Wide-field contact fundus photograph of an infant · 640 by 480 pixels · camera: Clarity RetCam 3 (130° FOV) — 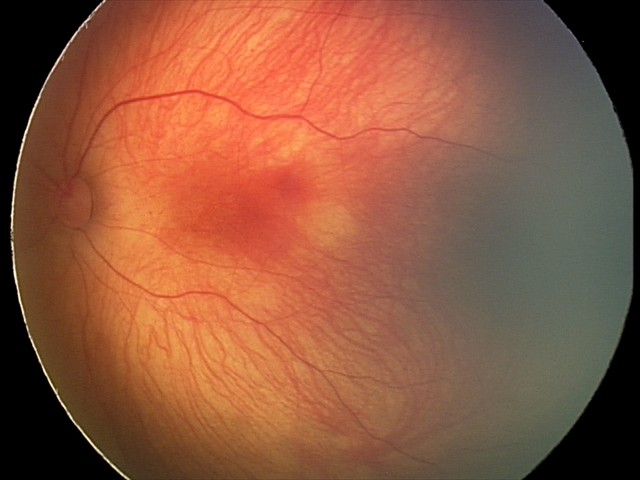
Series diagnosed as retinal hemorrhages.